Wide-field fundus photograph of an infant. 640 x 480 pixels:
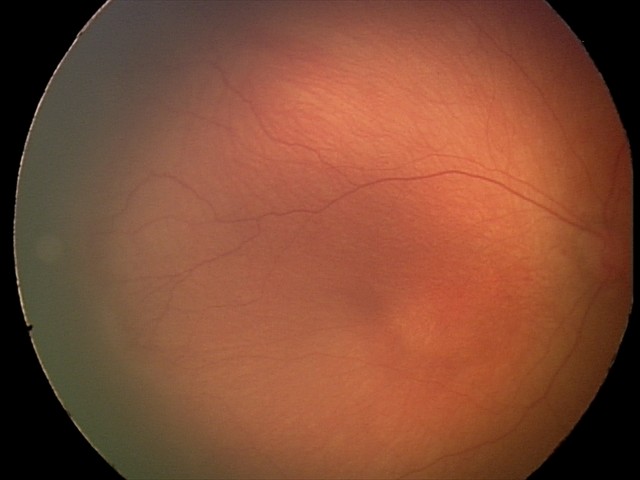
No plus disease.
Examination diagnosed as retinopathy of prematurity stage 1.